Graded on the modified Davis scale · nonmydriatic: 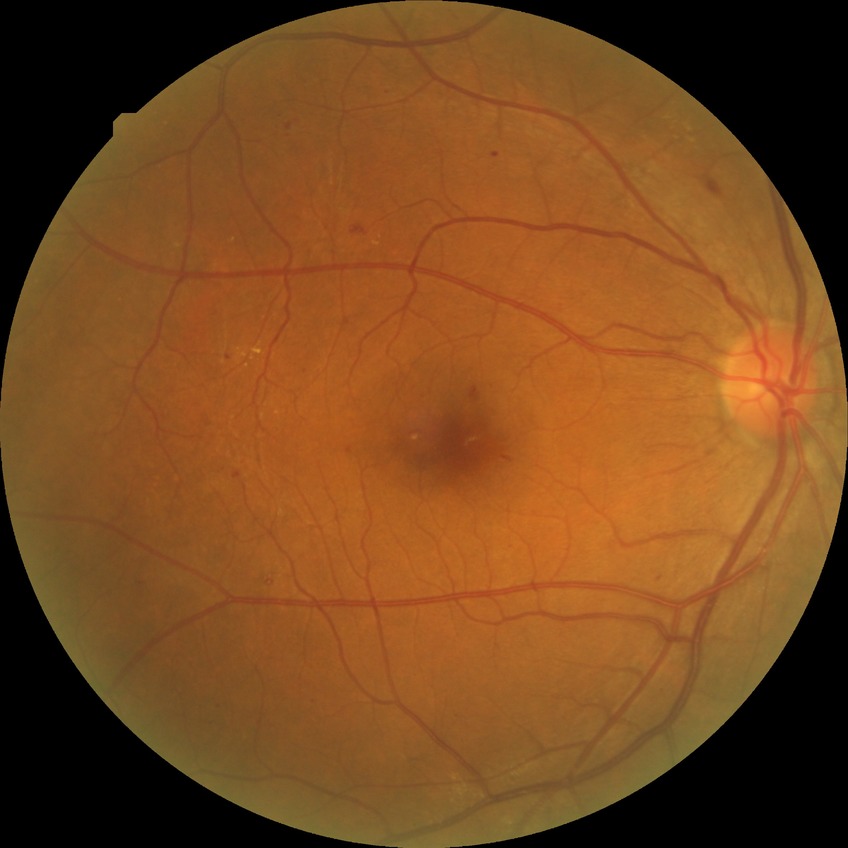

  davis_grade: SDR